45° field of view. Color fundus image. 1380x1382
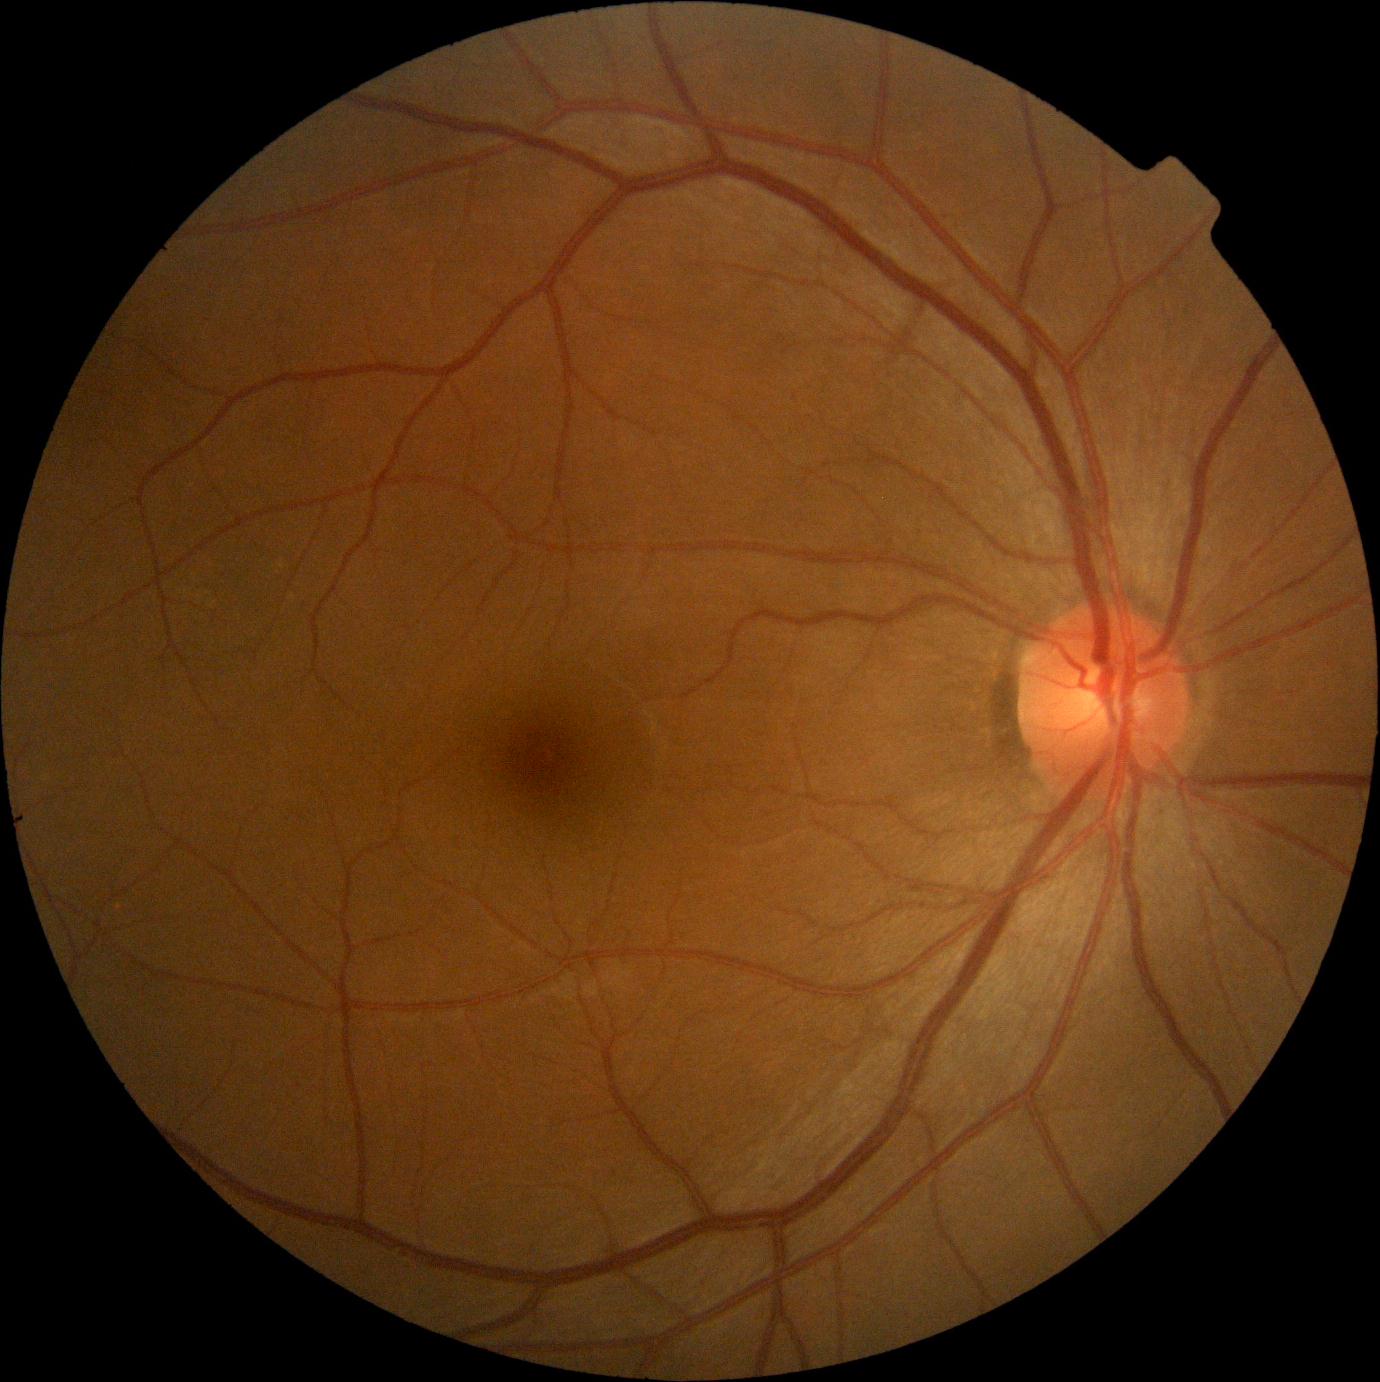
Annotations:
– DR impression — negative for DR
– DR grade — 0